Nonmydriatic, 848 by 848 pixels — 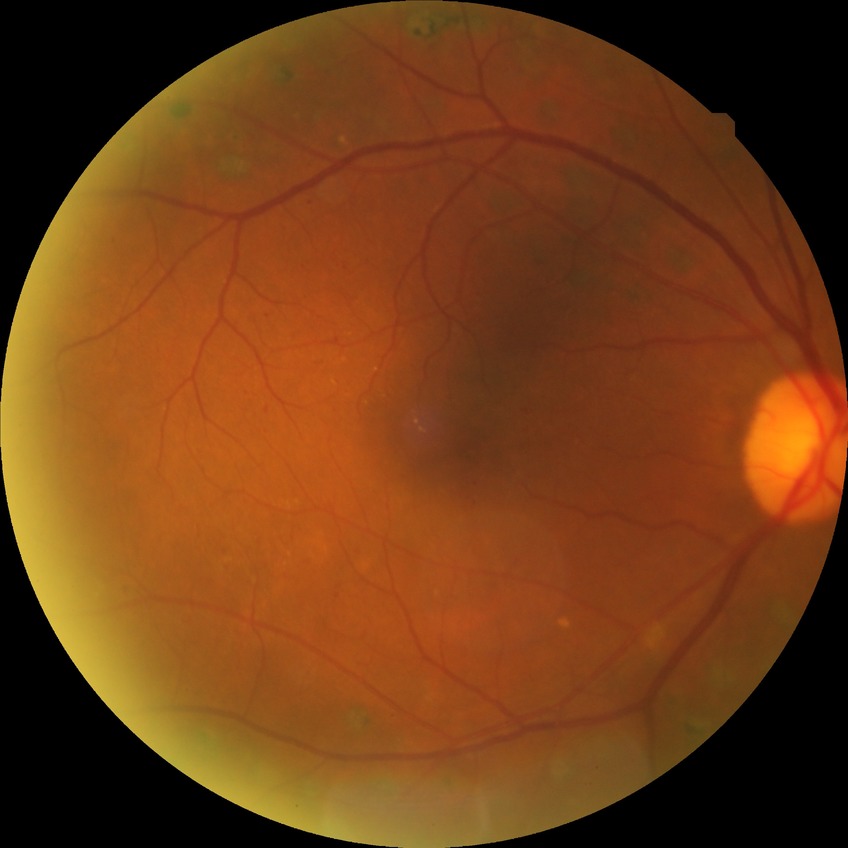 diabetic retinopathy (DR): proliferative diabetic retinopathy (PDR).